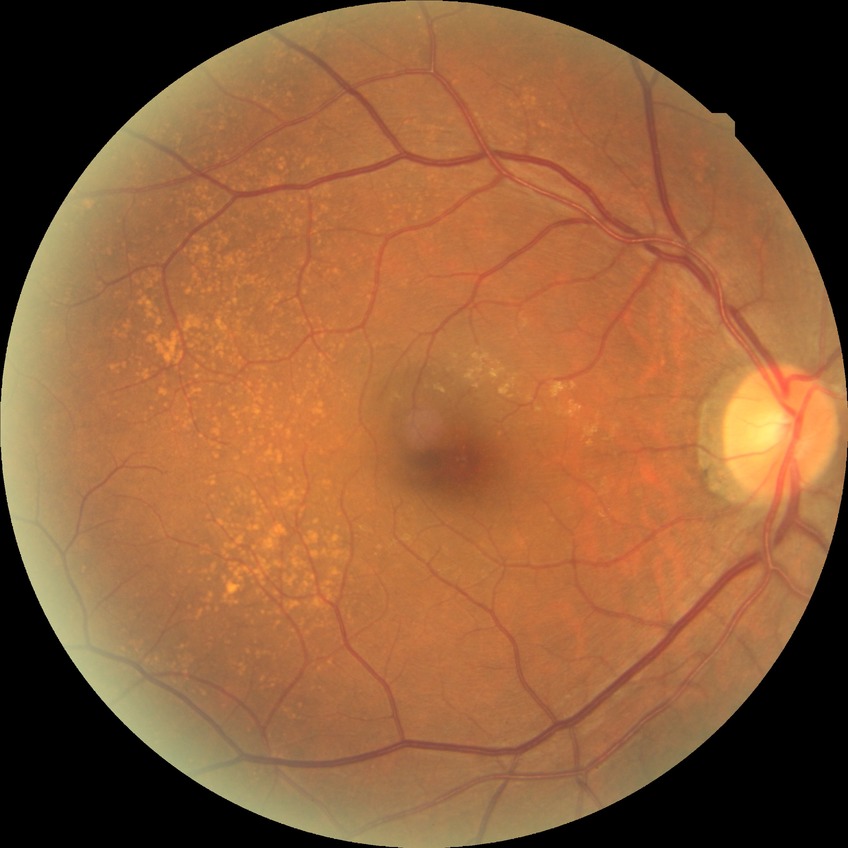 diabetic retinopathy (DR): NDR (no diabetic retinopathy).